45° FOV, 2212 x 1659 pixels.
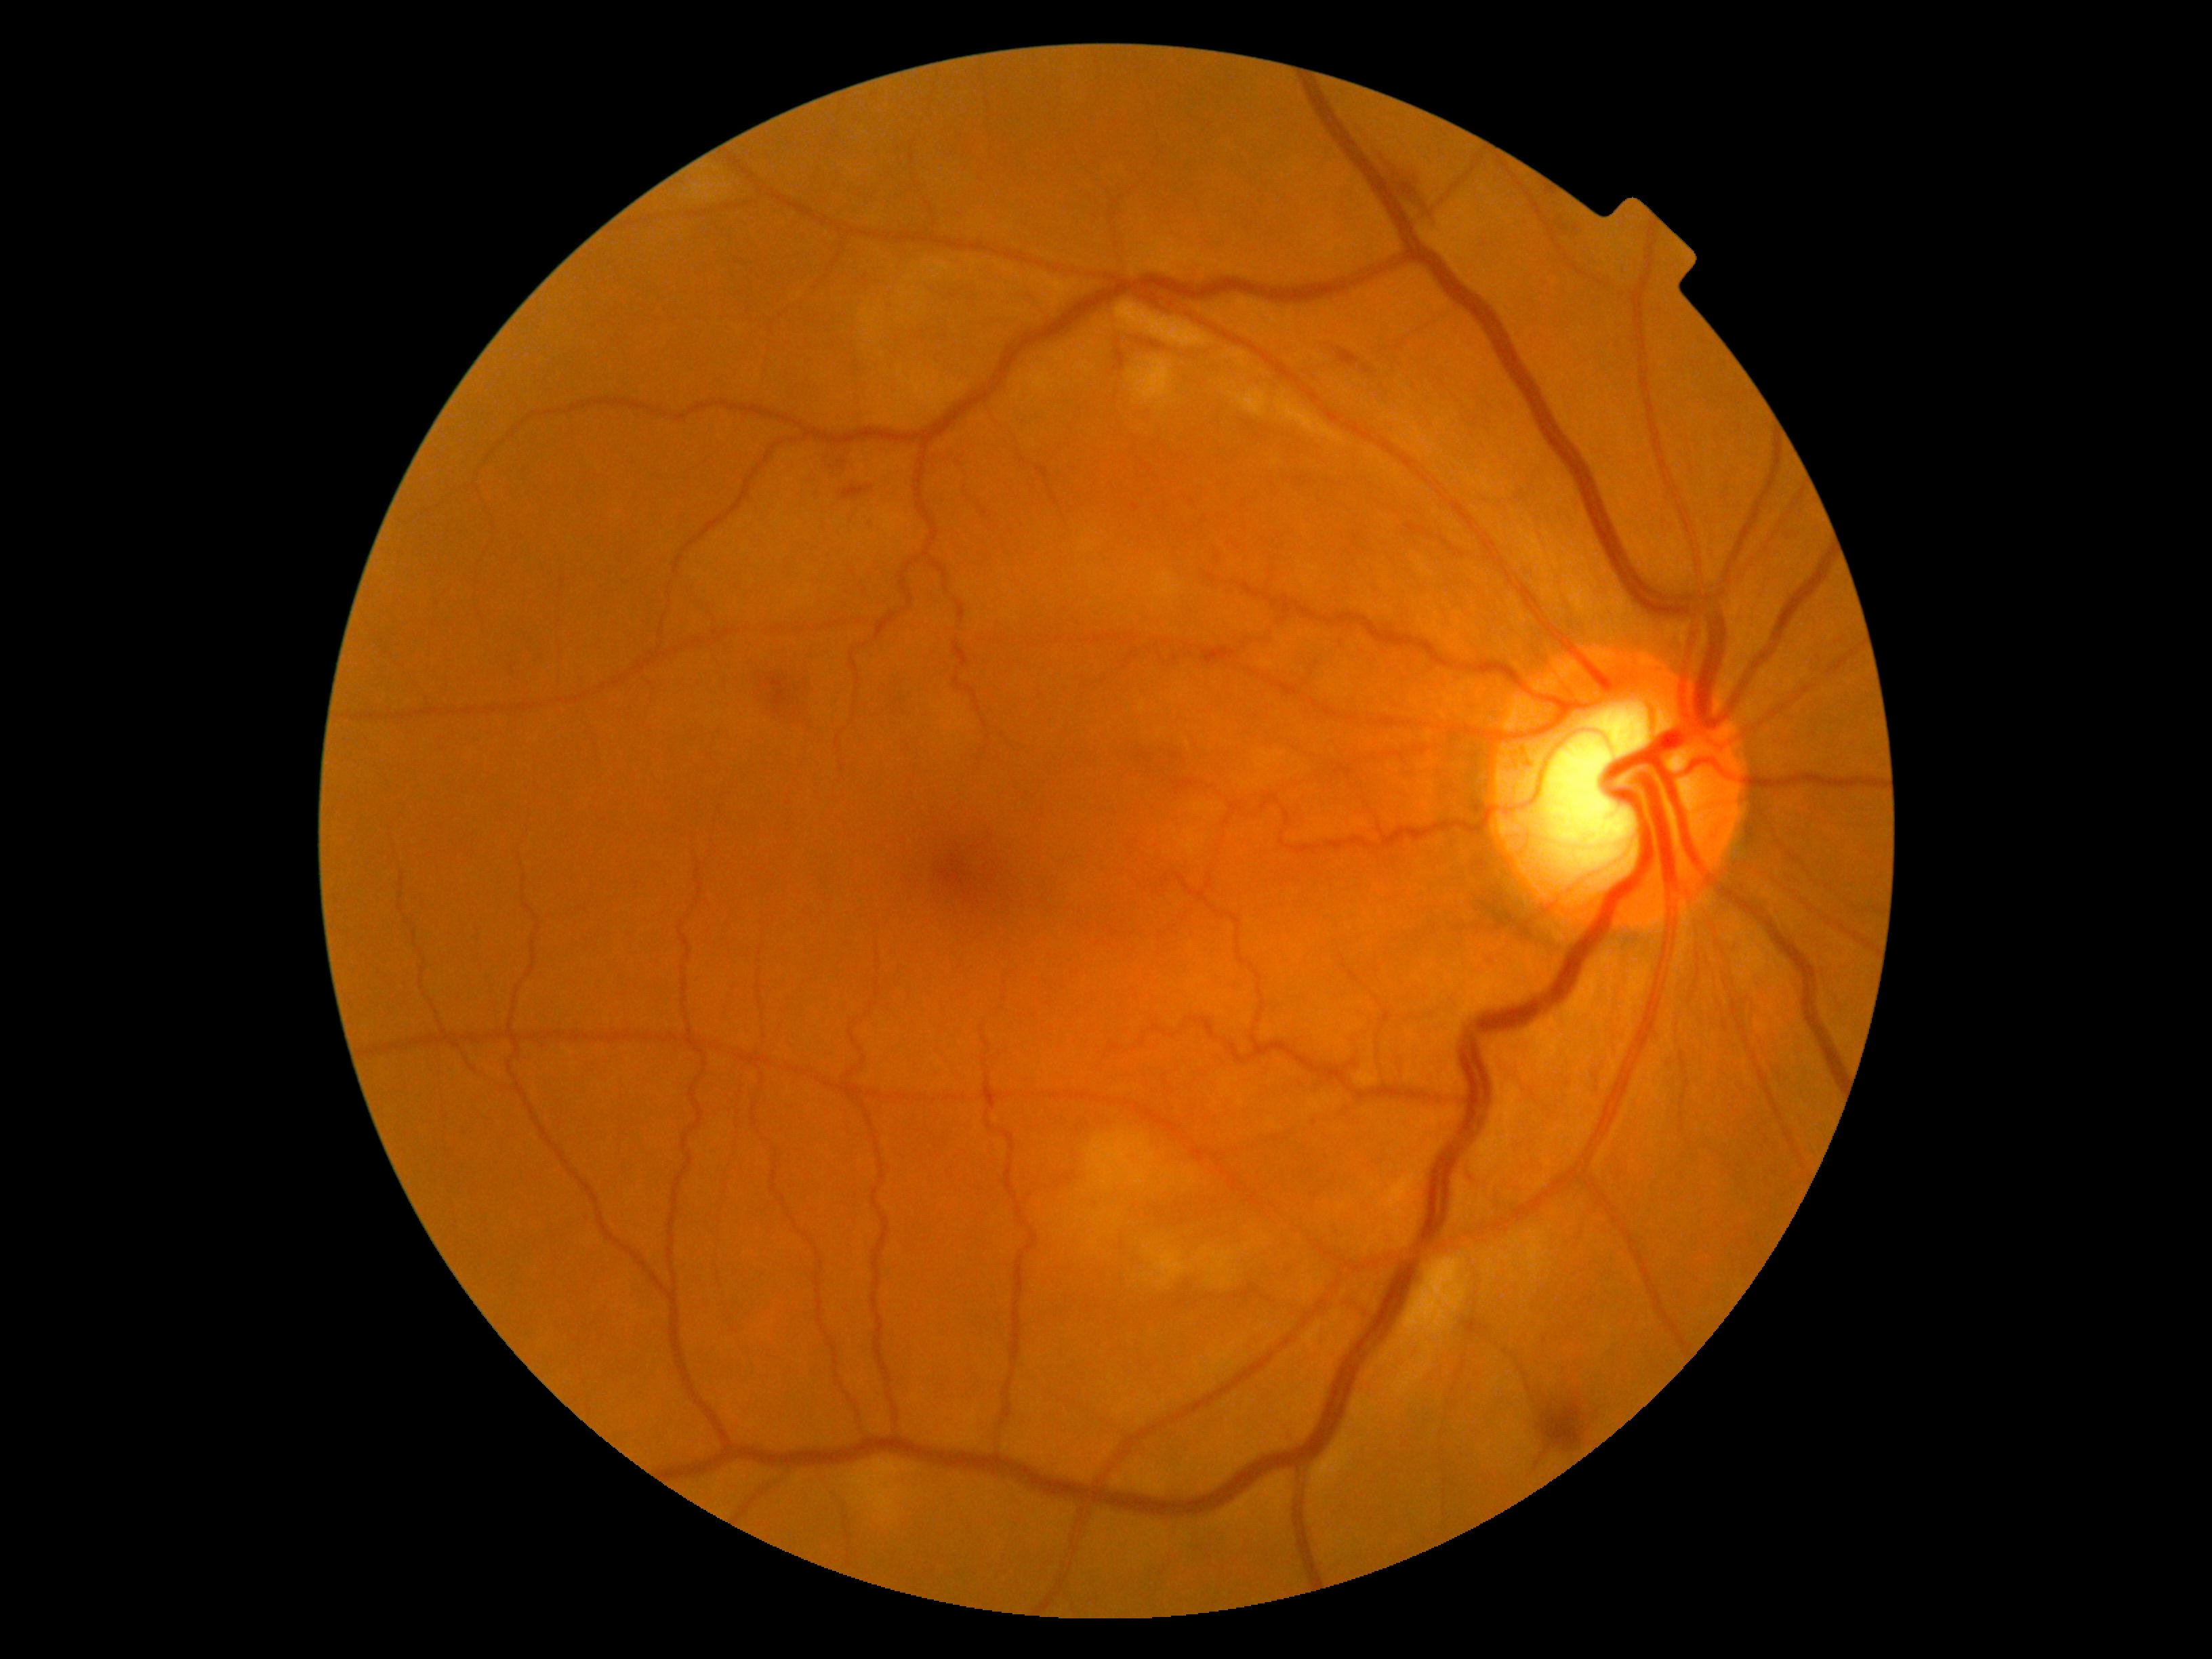 DR grade=2/4.